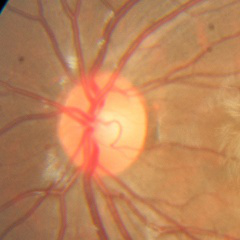 Glaucoma diagnosis = no glaucoma.